1659x2212, CFP, captured on a Remidio Fundus on Phone: 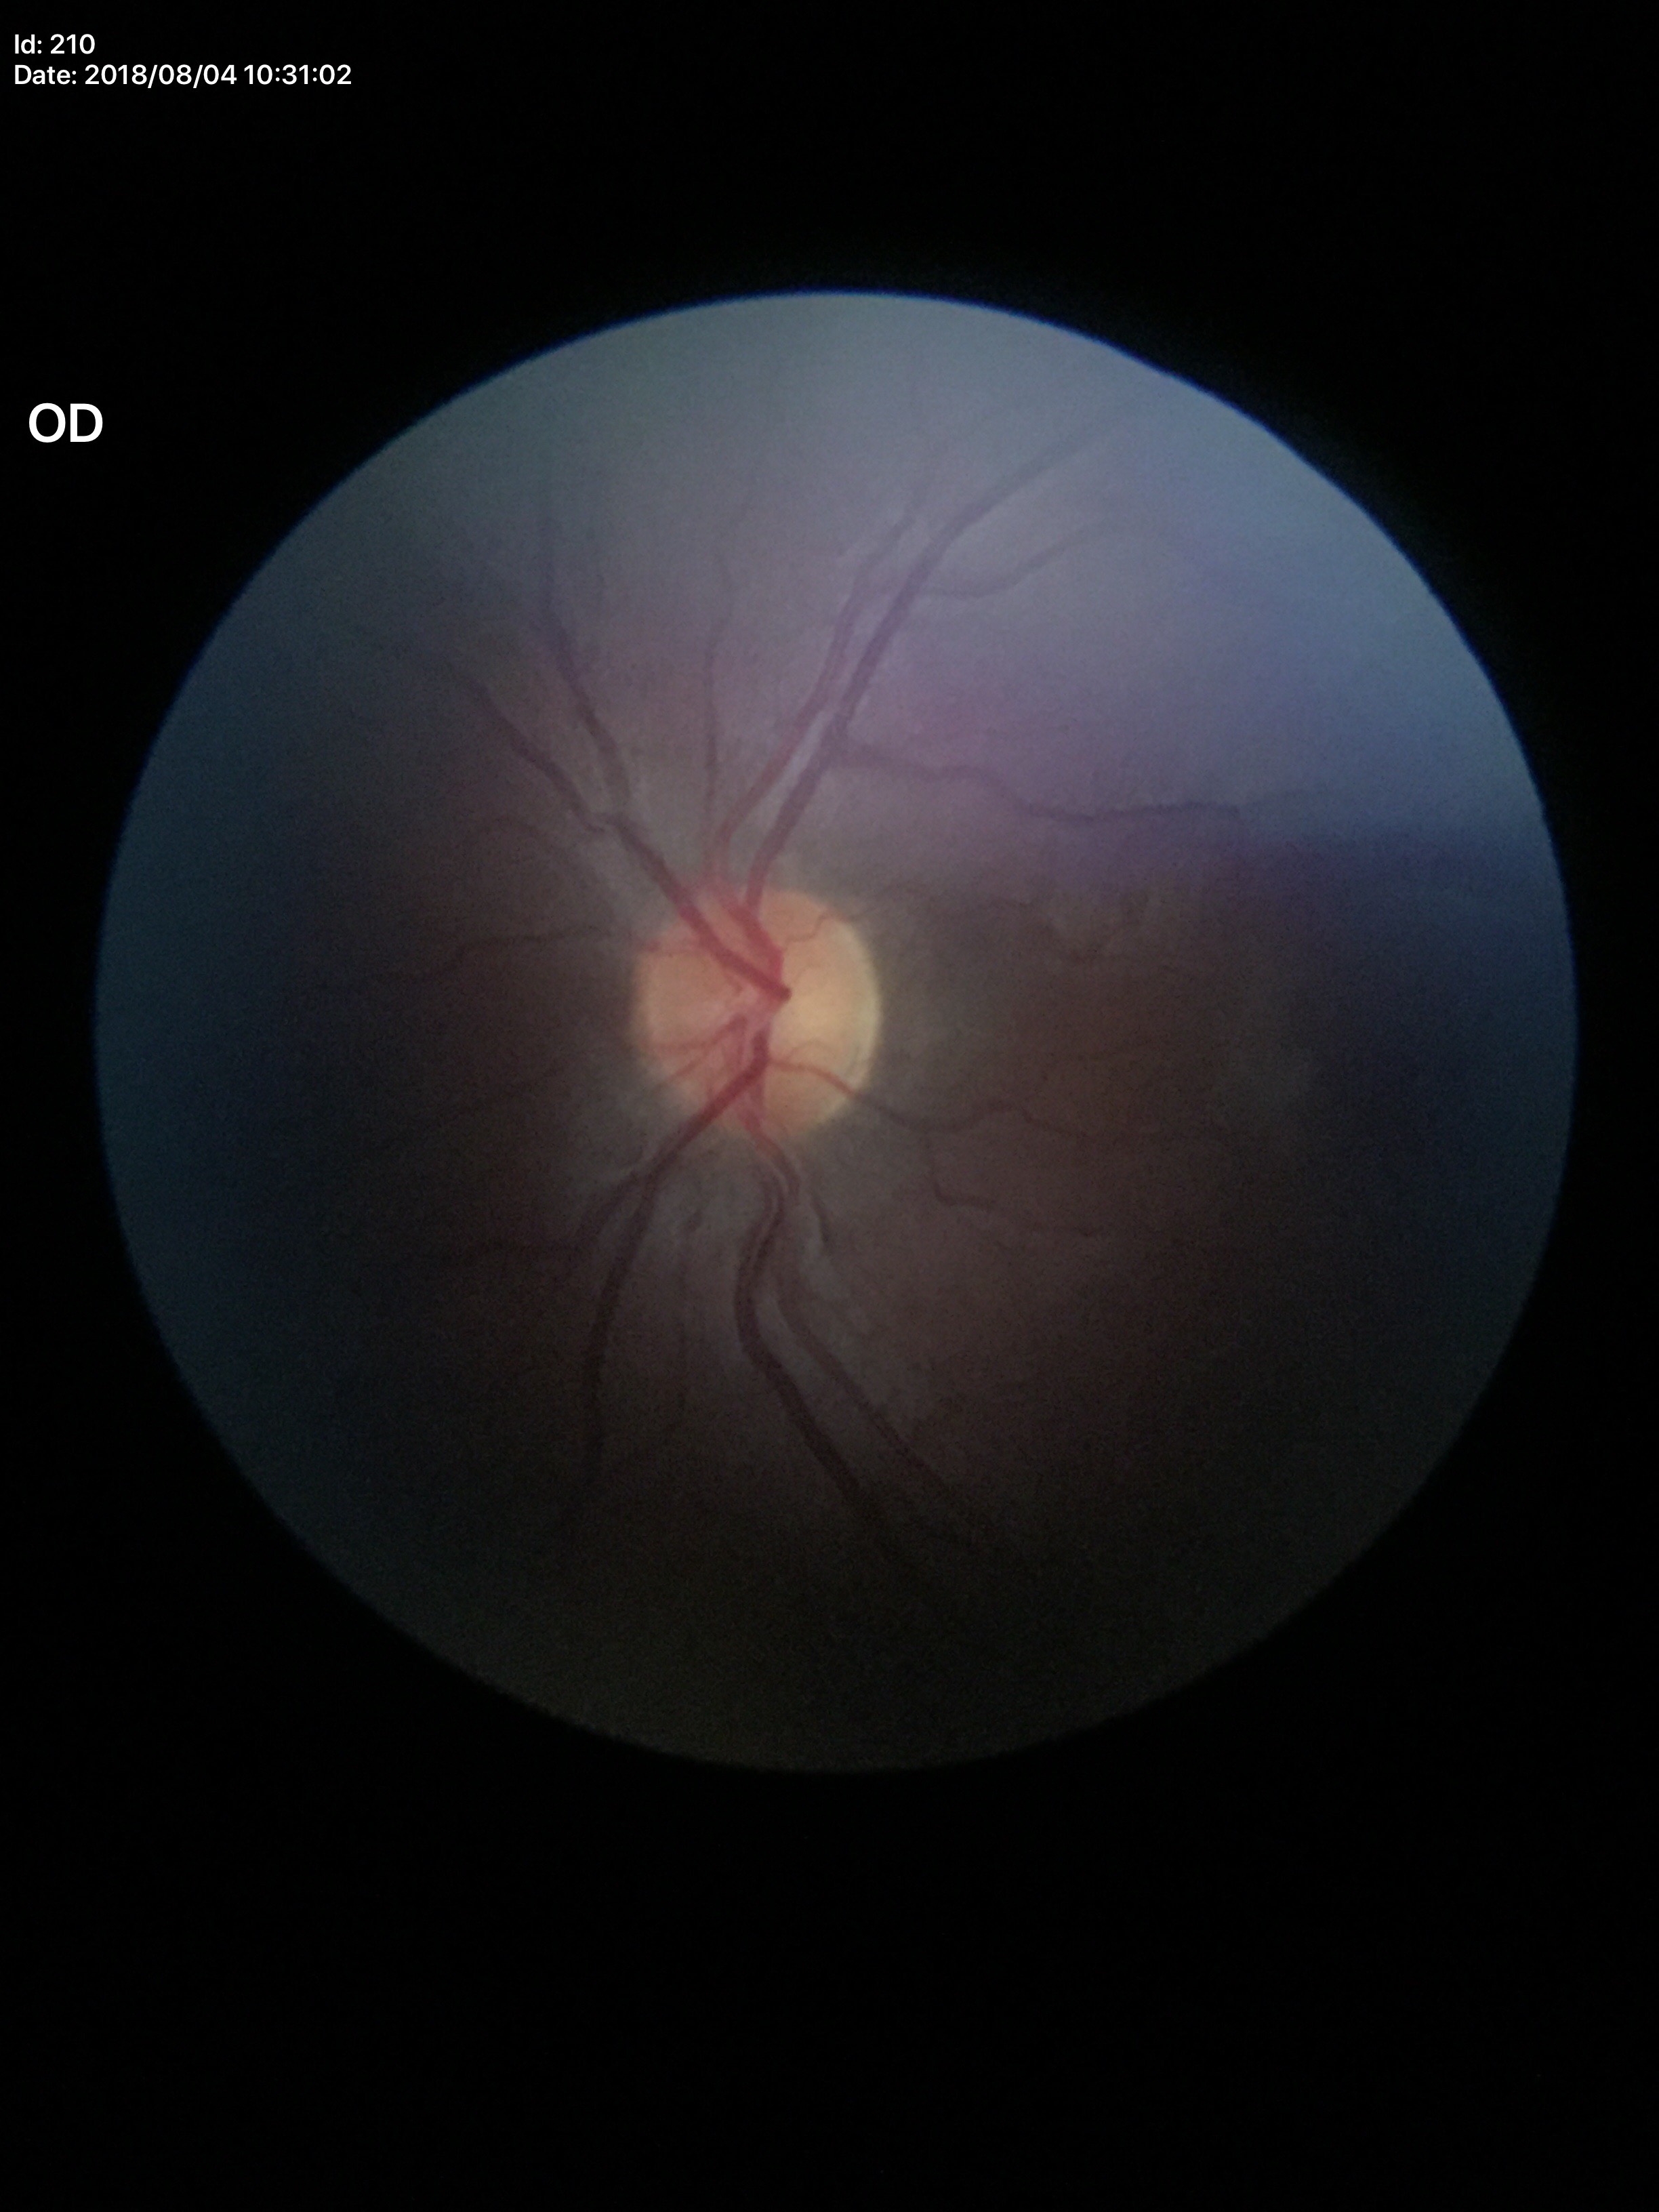
HCDR of 0.47. VCDR is 0.49. Glaucoma impression: no suspicious findings.